Retinal fundus photograph — 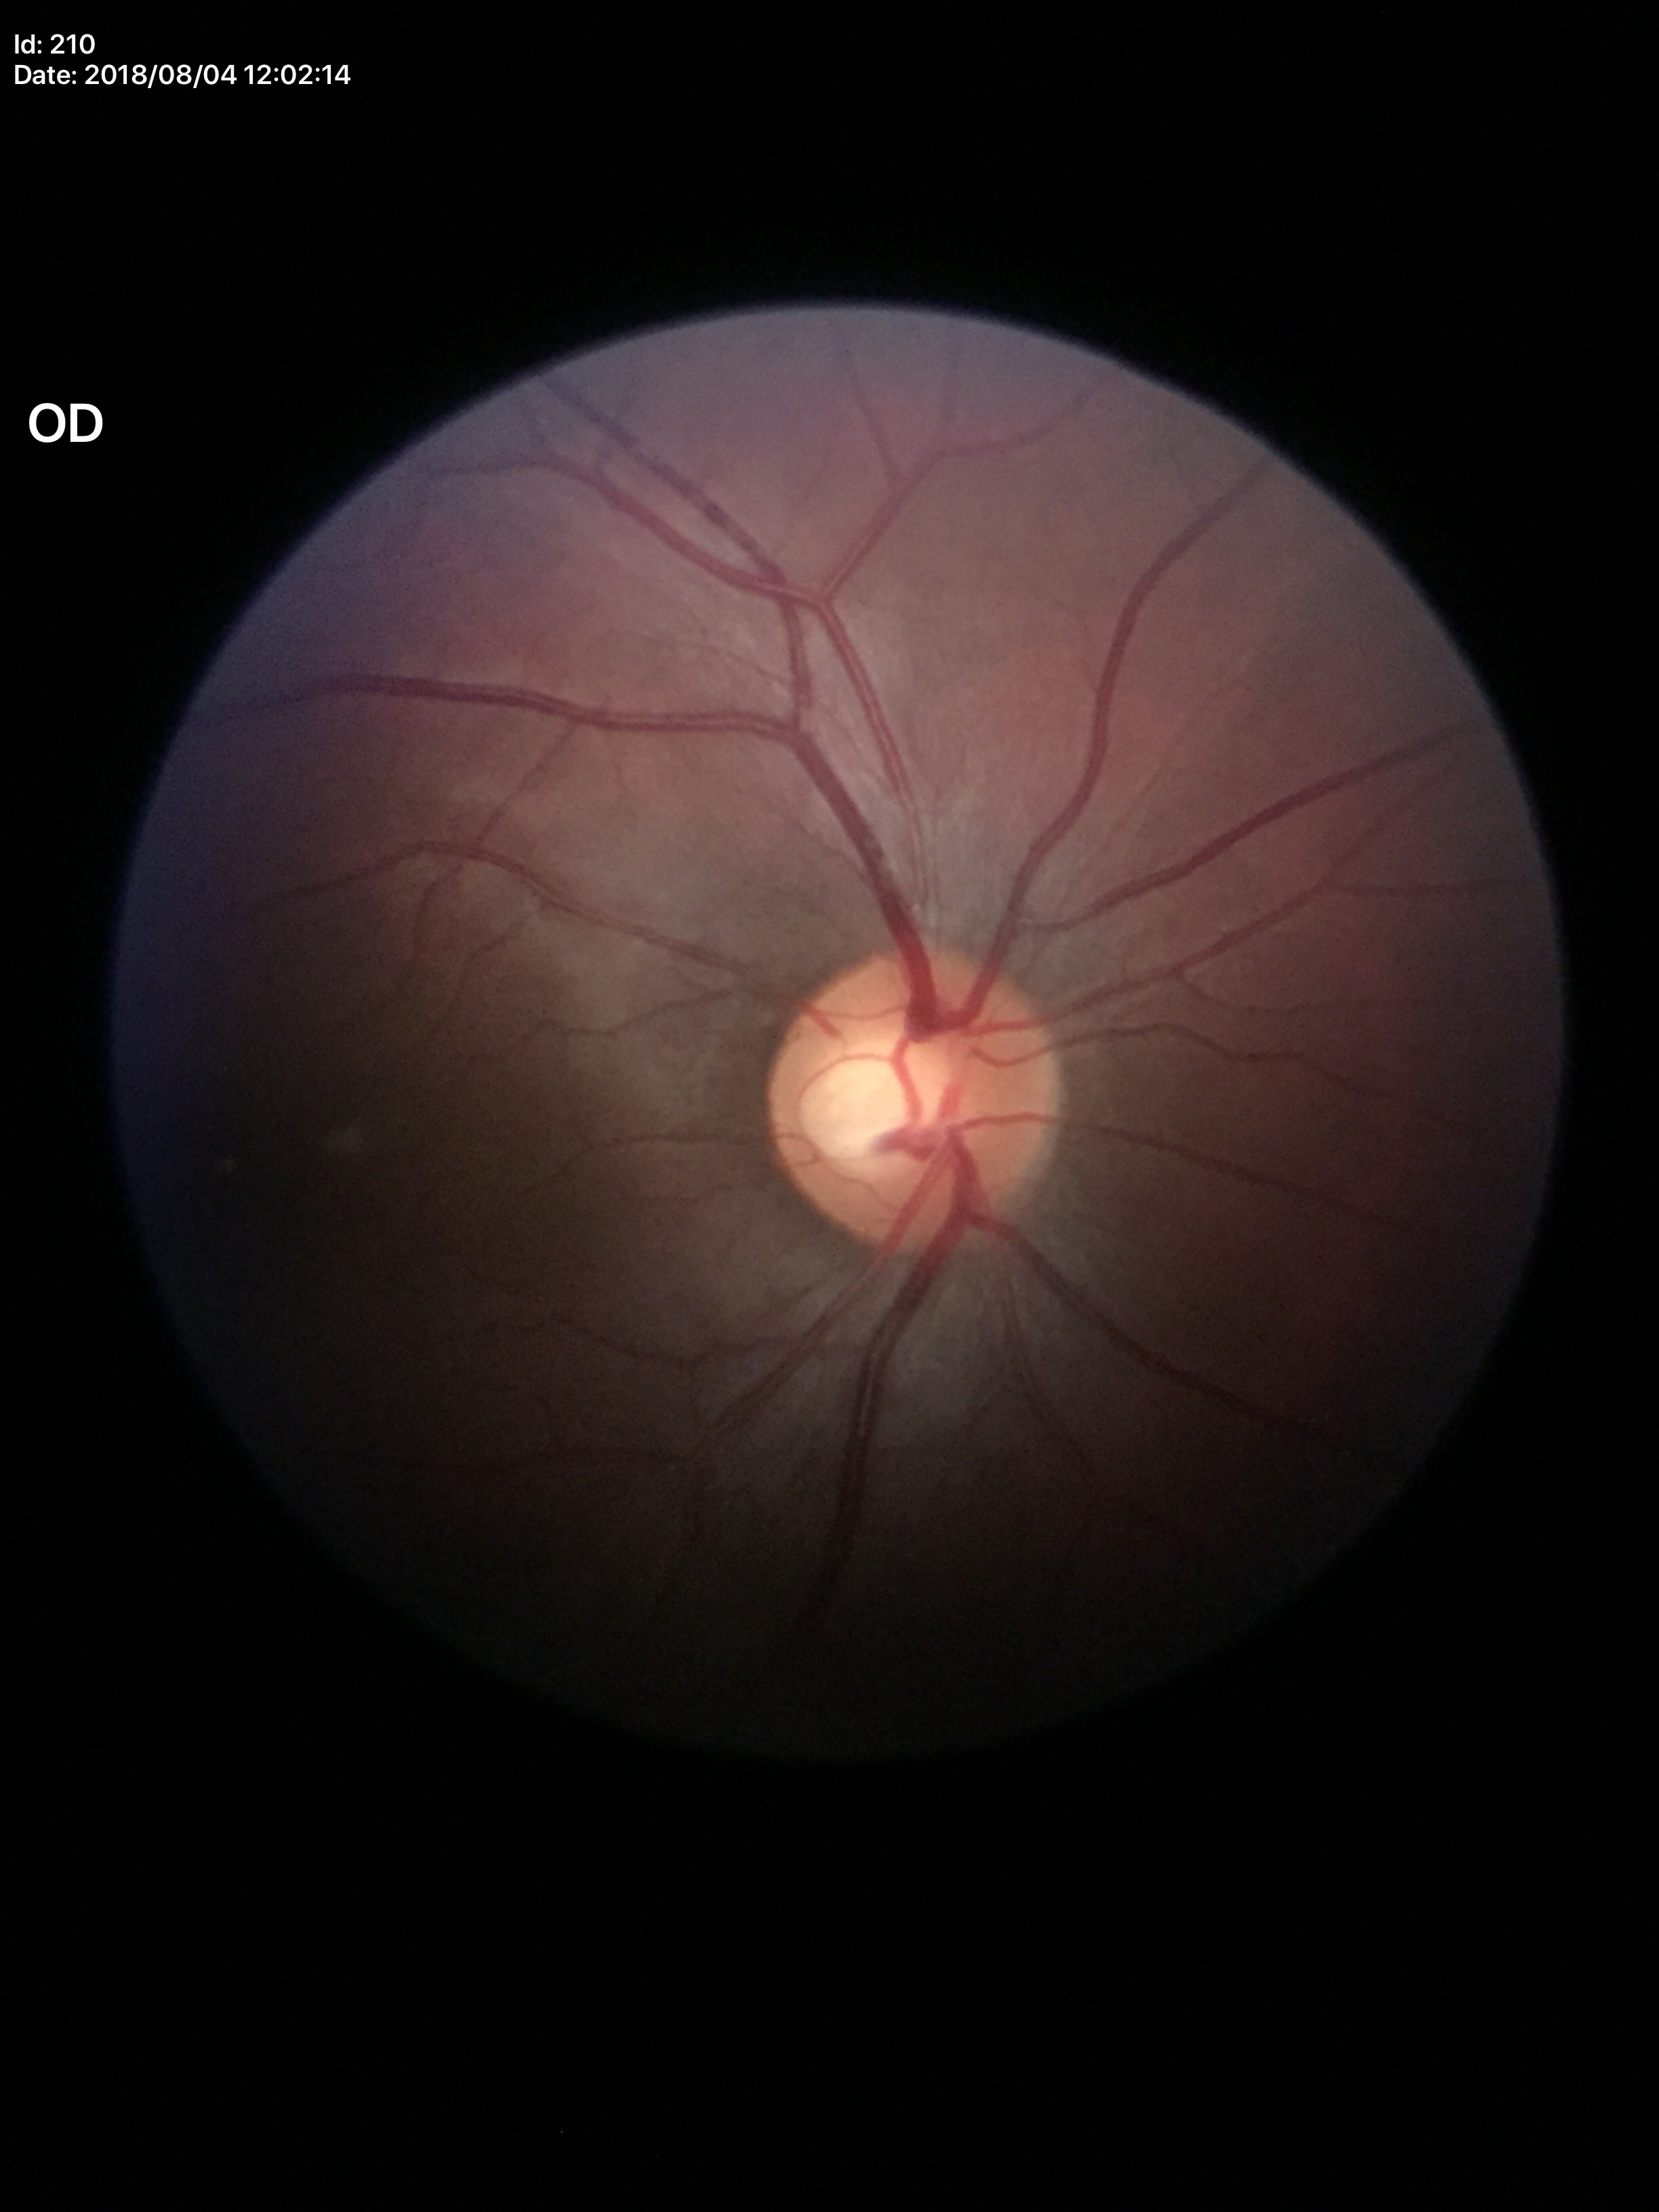

Glaucoma evaluation: not suspect (2 of 5 graders flagged glaucoma suspect).
Vertical C/D ratio (VCDR) of 0.61.